Macula-centered field; color fundus image; 50-degree field of view; image size 2361x1568: 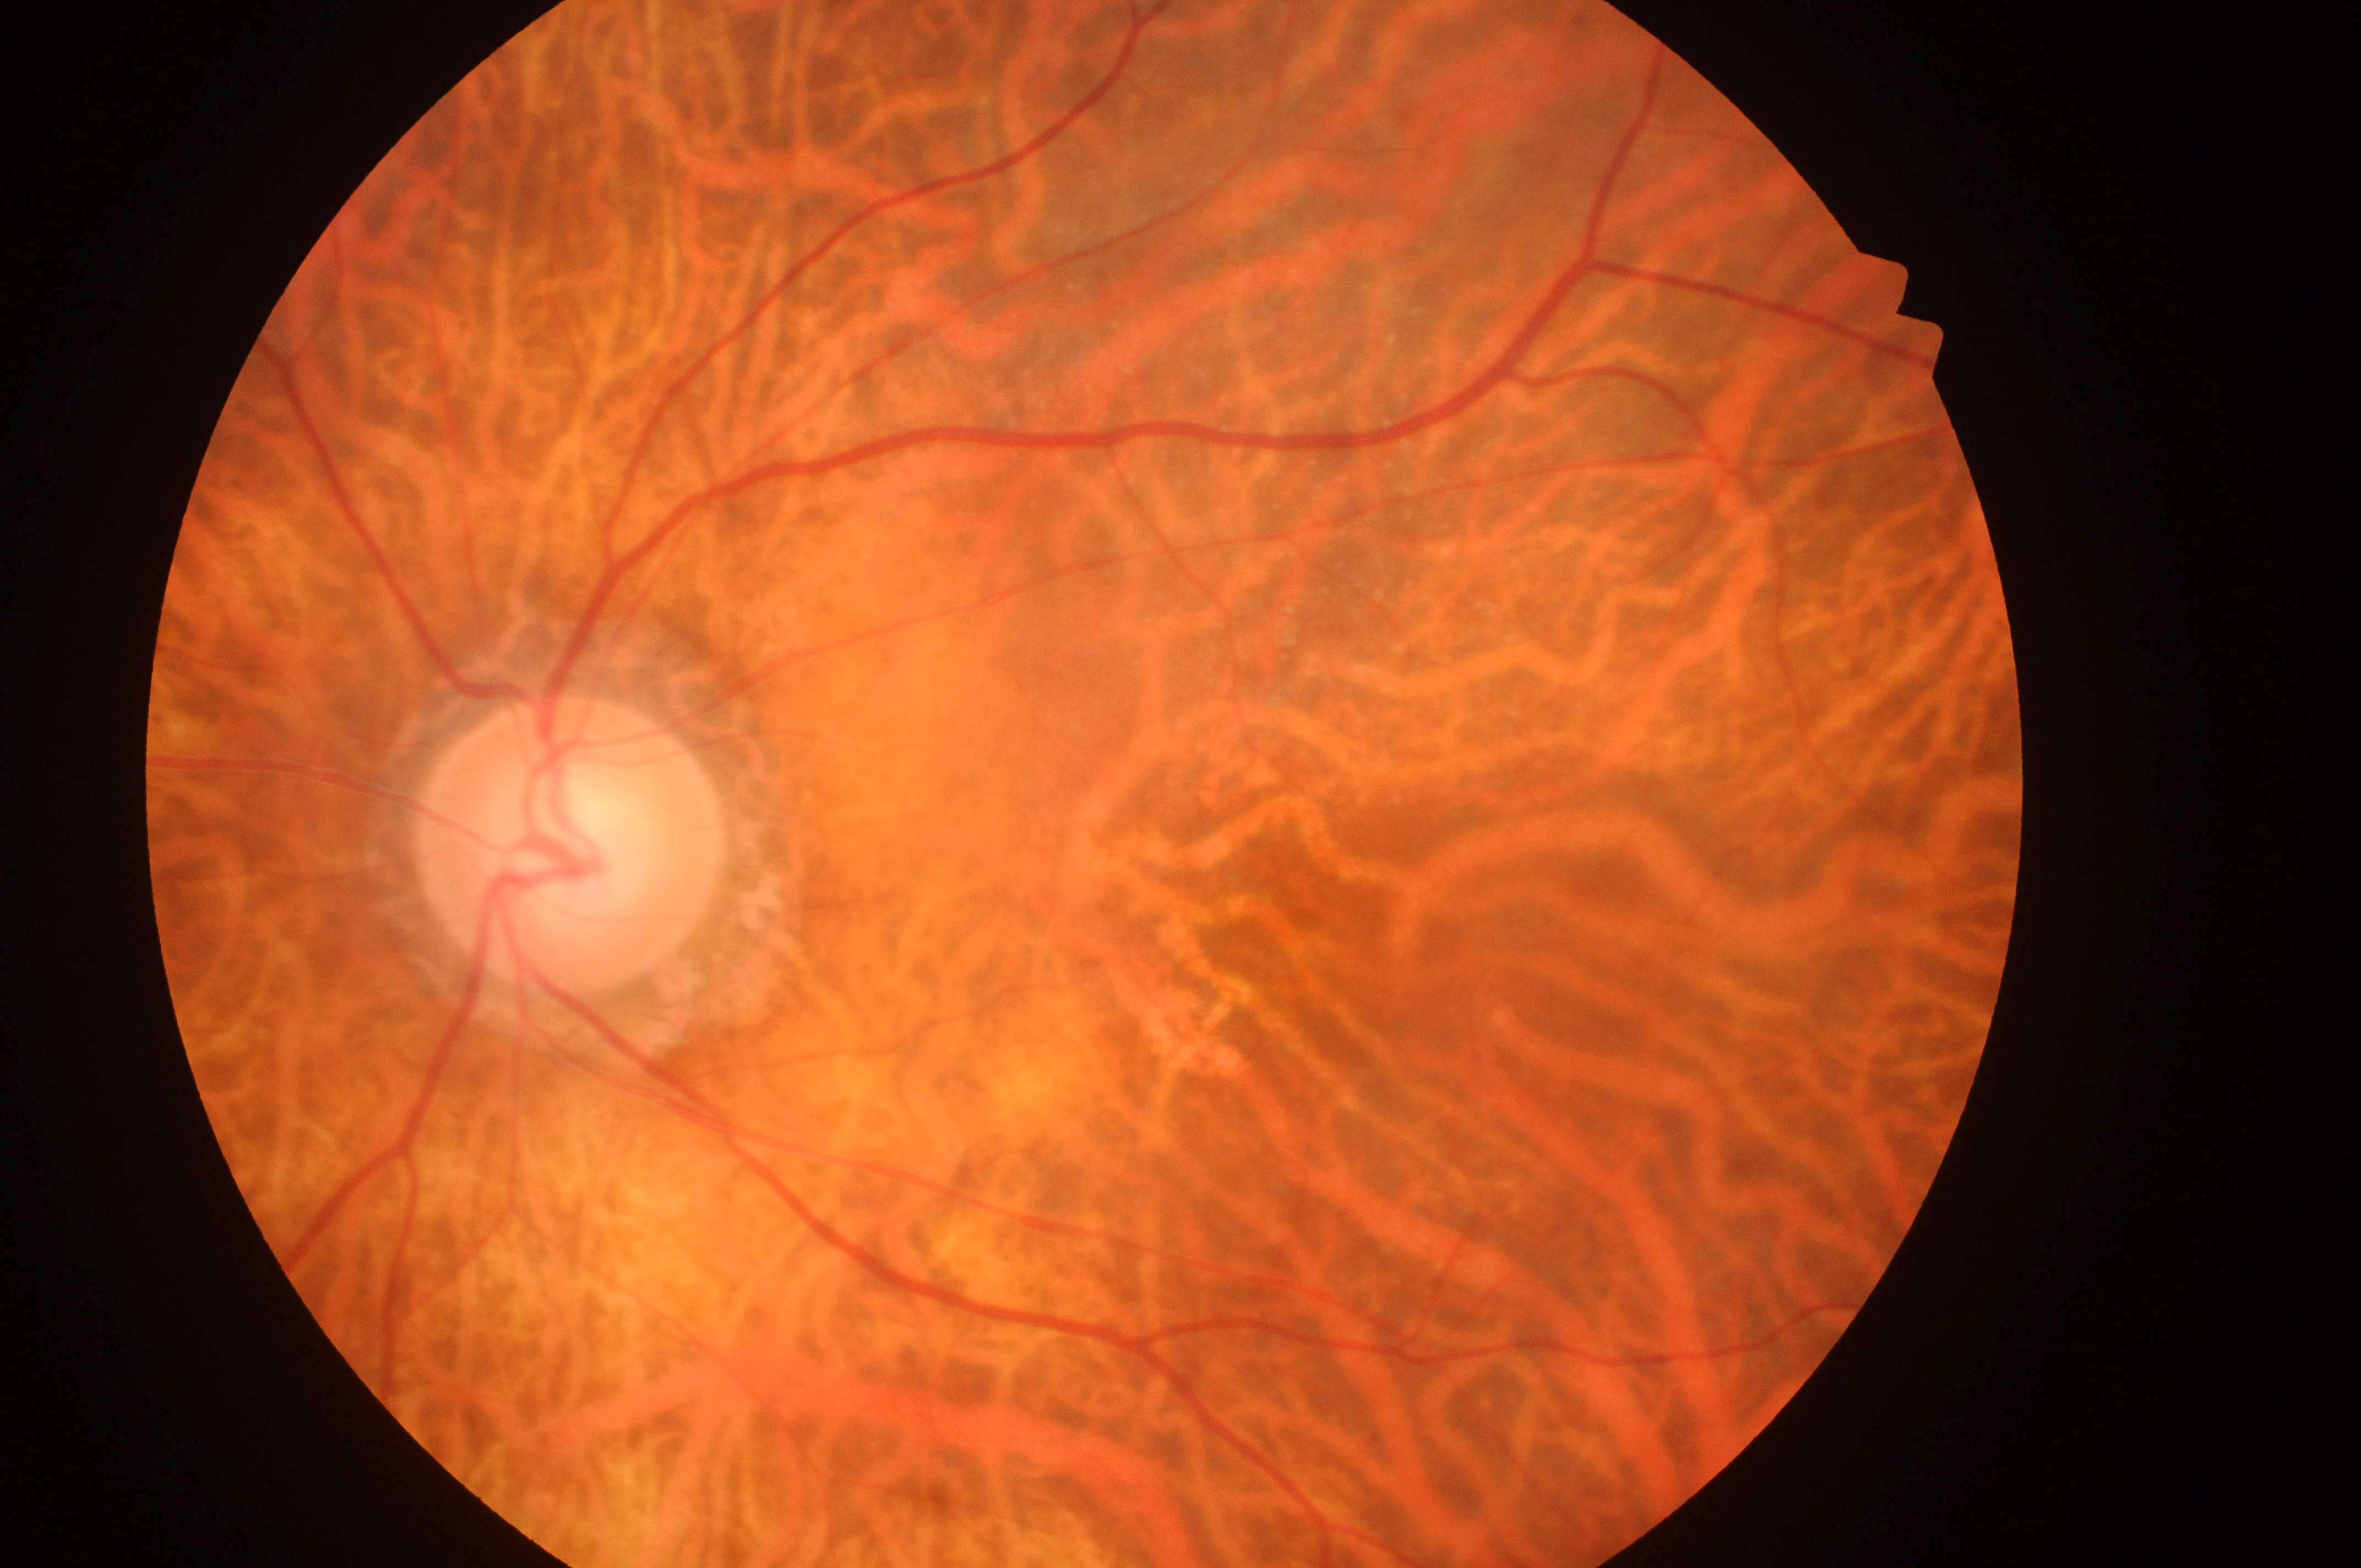

disc center = (x: 559, y: 853); fovea centralis = (x: 1285, y: 907); laterality = oculus sinister; diabetic retinopathy (DR) = 0/4; diabetic macular edema (DME) = grade 0.